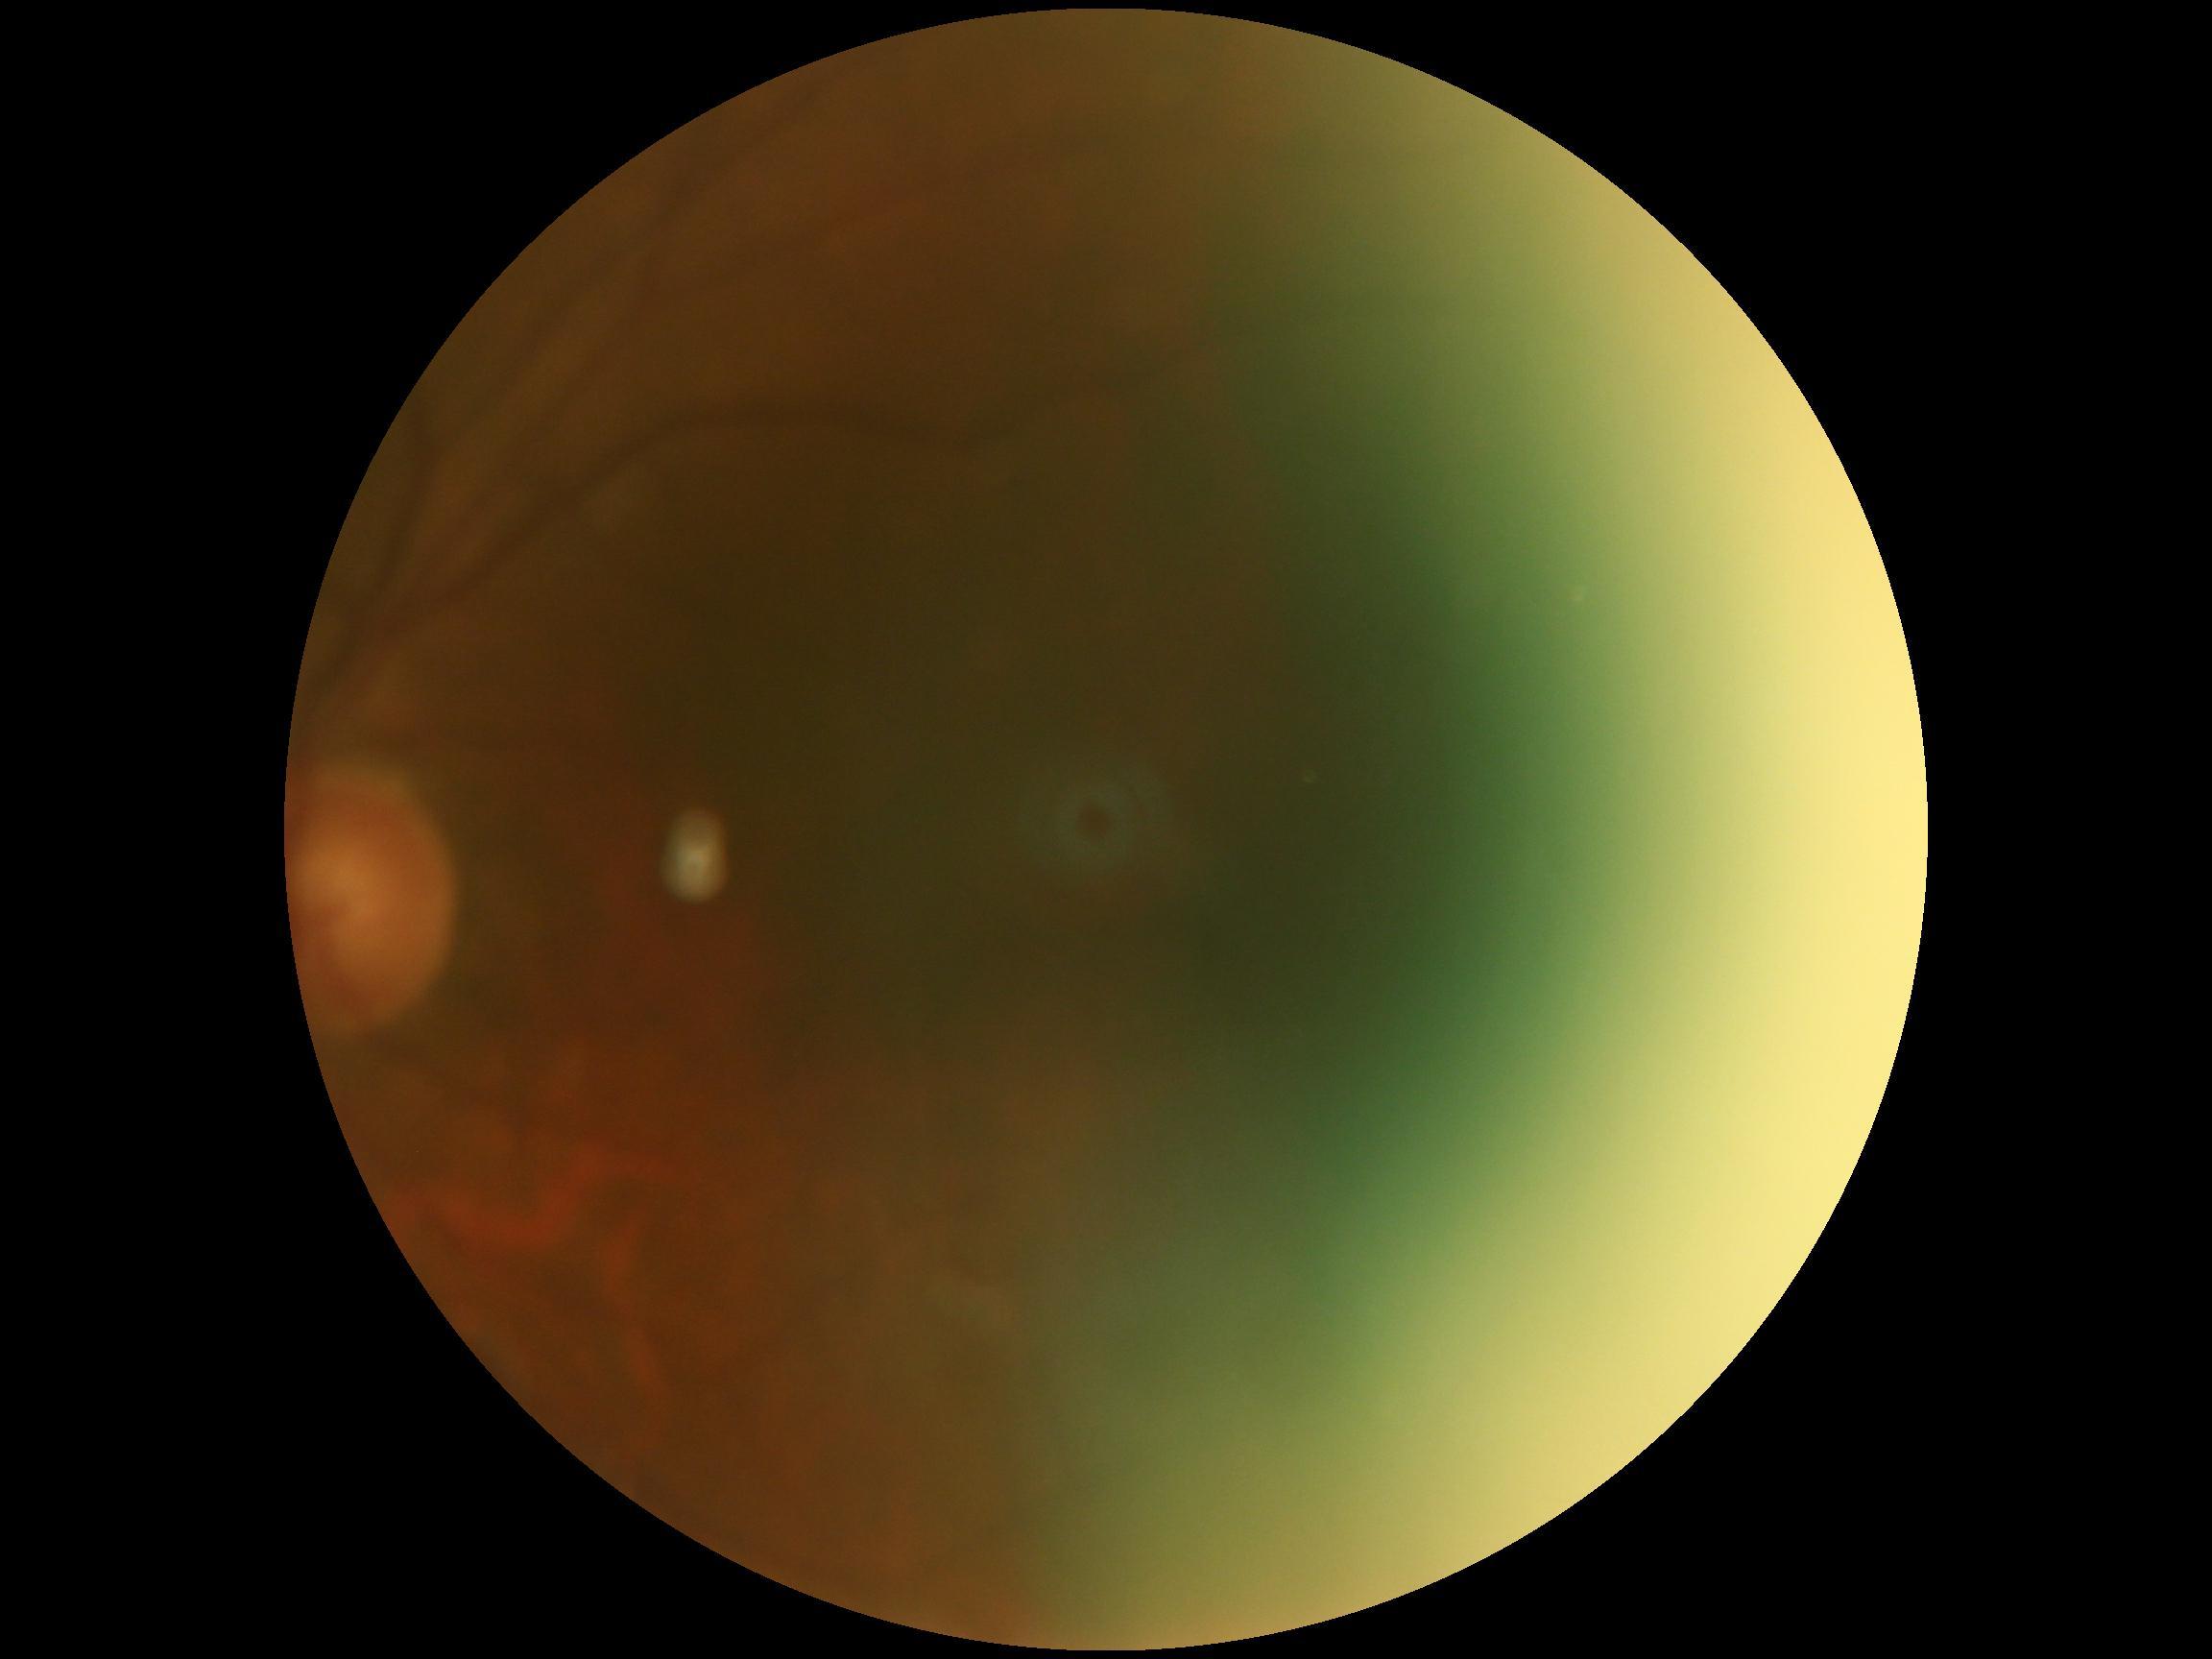
Diabetic retinopathy (DR) is ungradable.